NIDEK AFC-230, posterior pole color fundus photograph, 848 x 848 pixels.
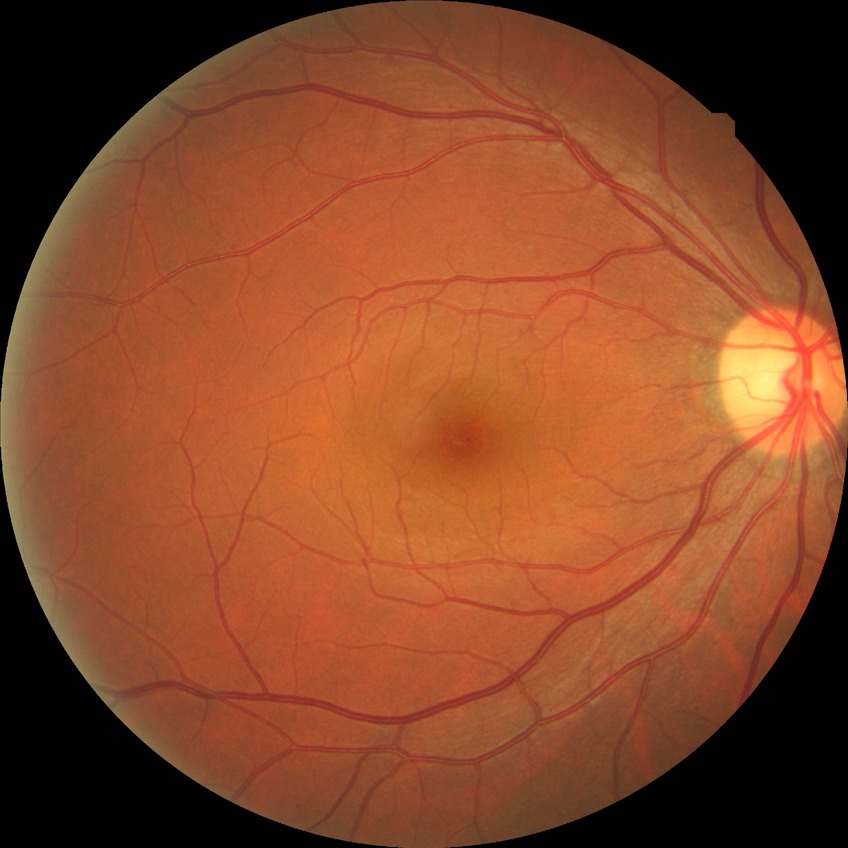 Assessment:
* diabetic retinopathy (DR) — SDR (simple diabetic retinopathy)